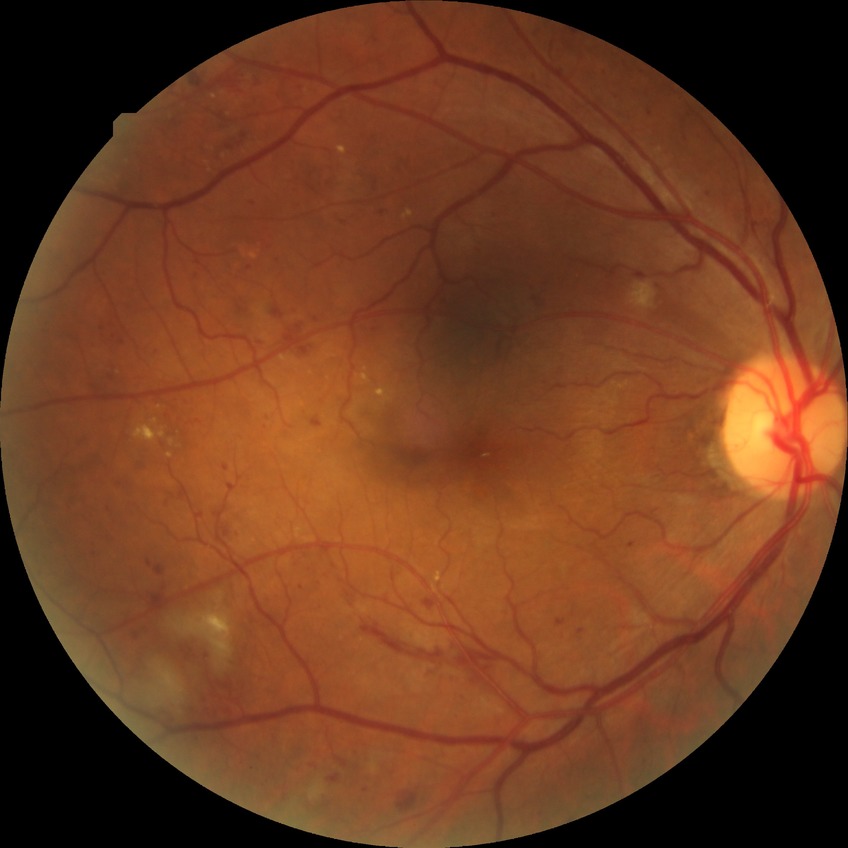

Diabetic retinopathy (DR) is pre-proliferative diabetic retinopathy (PPDR).